Captured after pupil dilation — 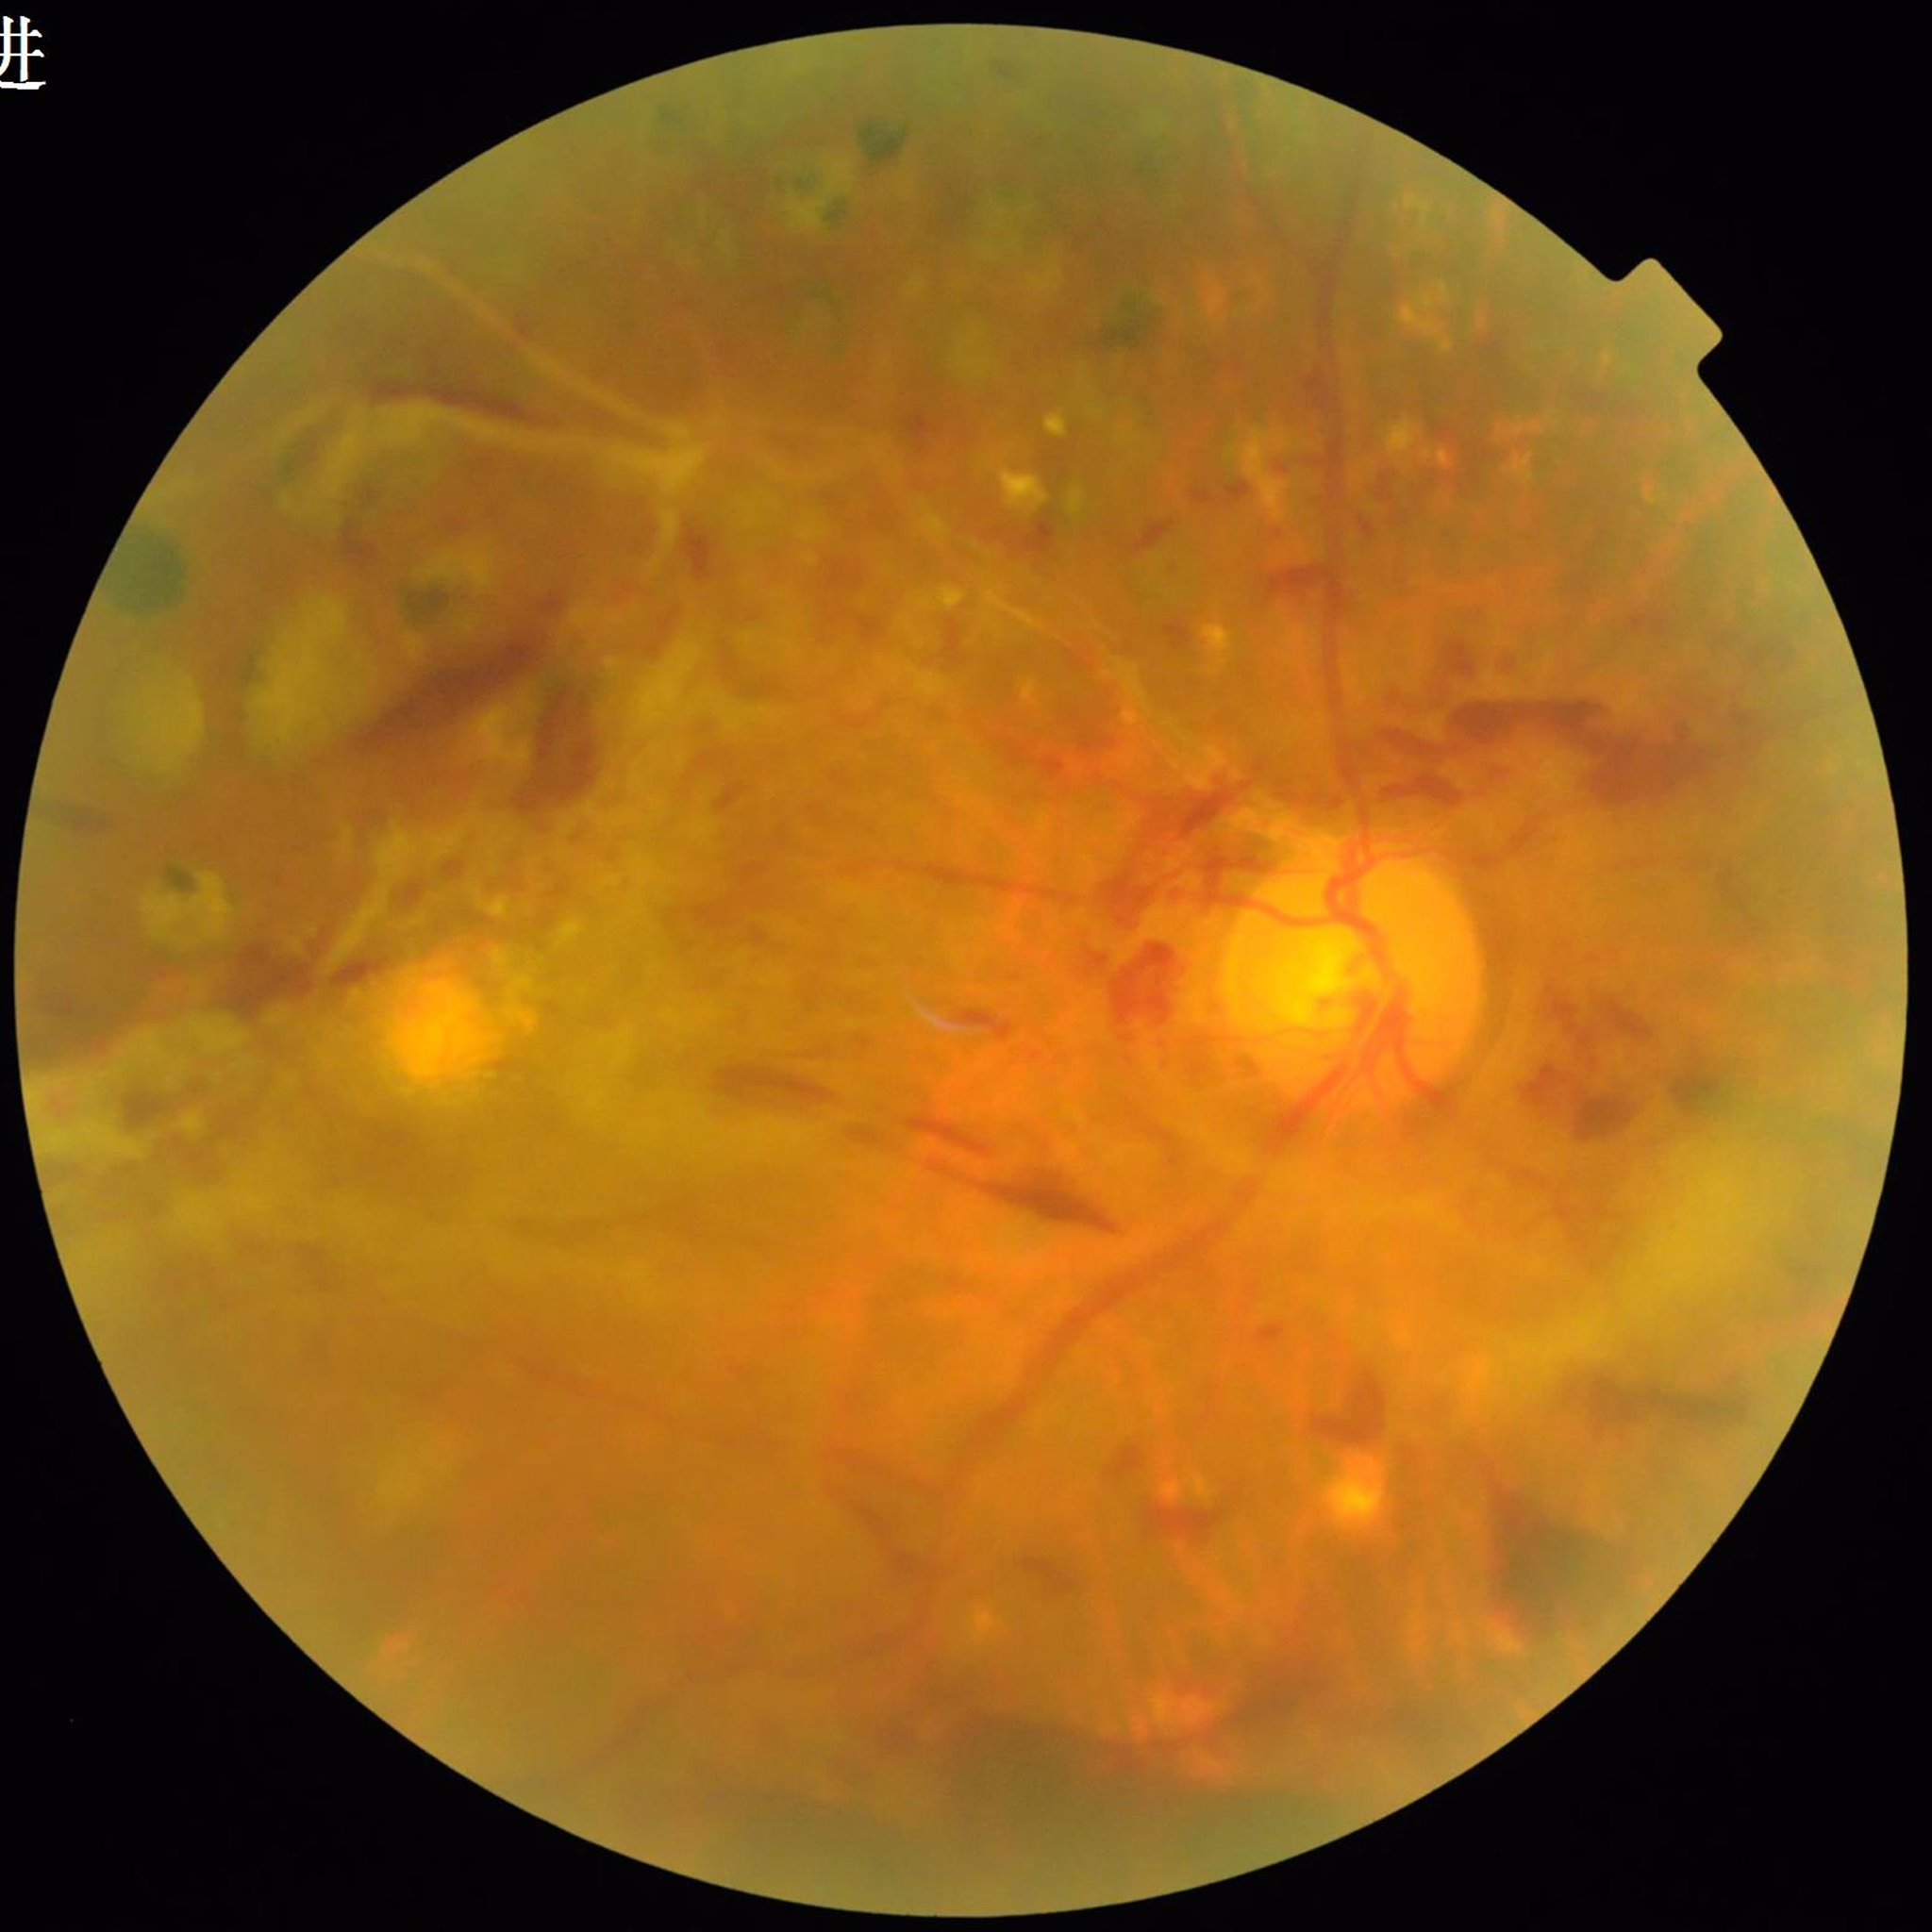

Quality: contrast adequate, blur present, illumination and color satisfactory. Eye affected by DR.